Posterior pole photograph · DR severity per modified Davis staging · FOV: 45 degrees · without pupil dilation · 848x848px · NIDEK AFC-230
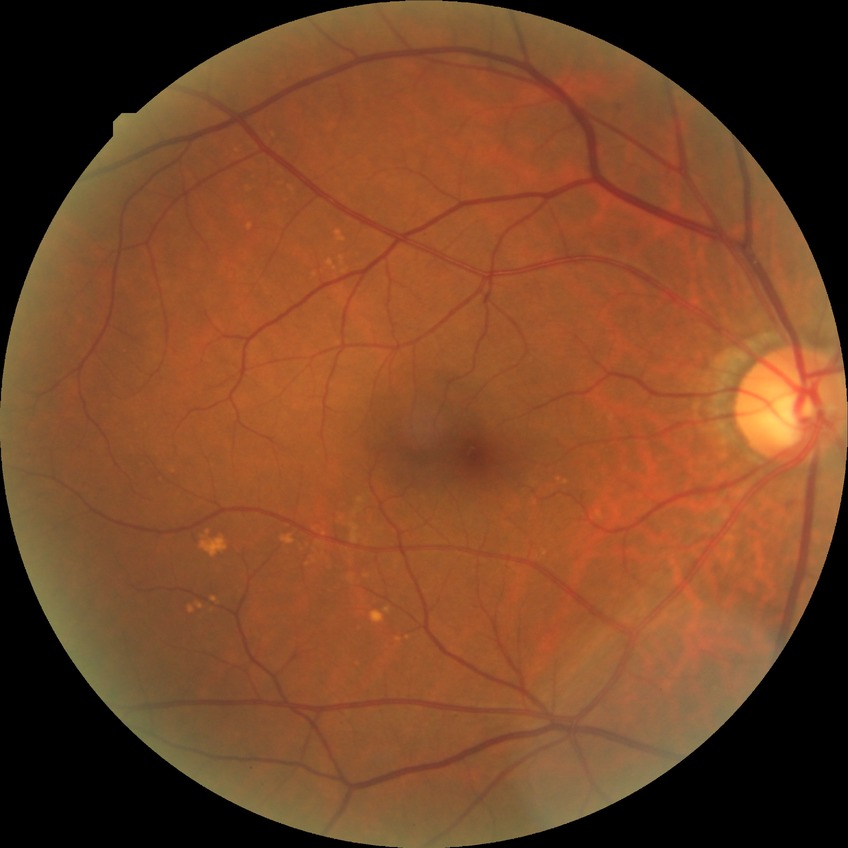 – DR impression: no apparent DR
– modified Davis grade: NDR